Infant wide-field retinal image · 1440x1080.
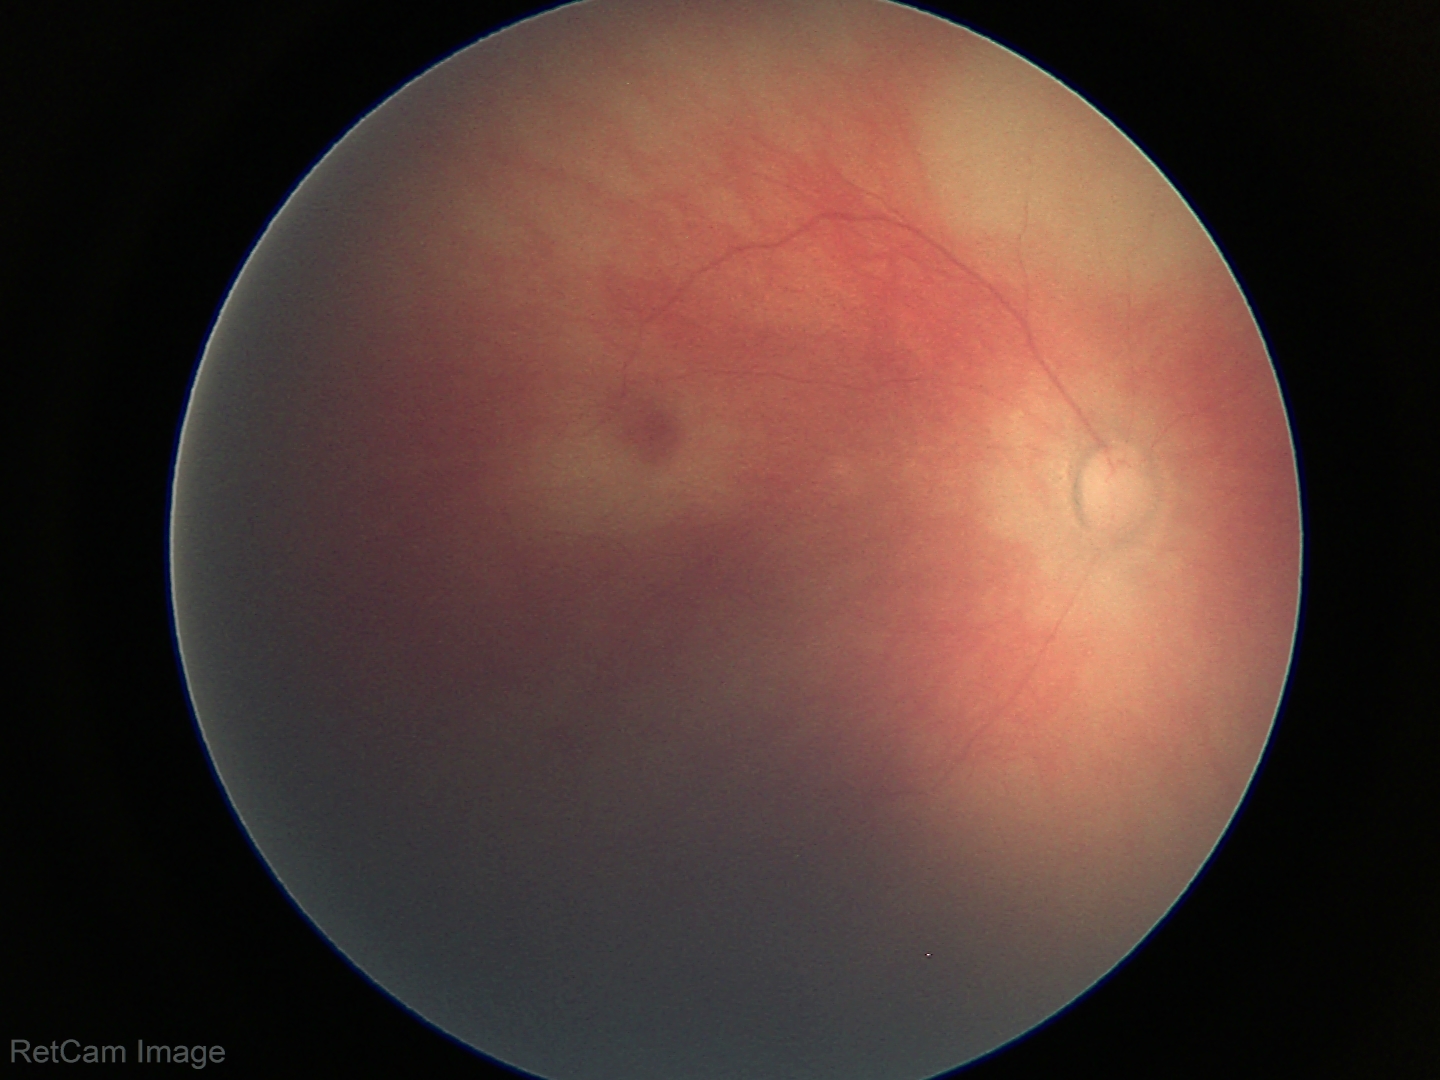
Physiological retinal appearance for postconceptual age.